Without pupil dilation · color fundus photograph · 848 x 848 pixels · 45° field of view · camera: NIDEK AFC-230 — 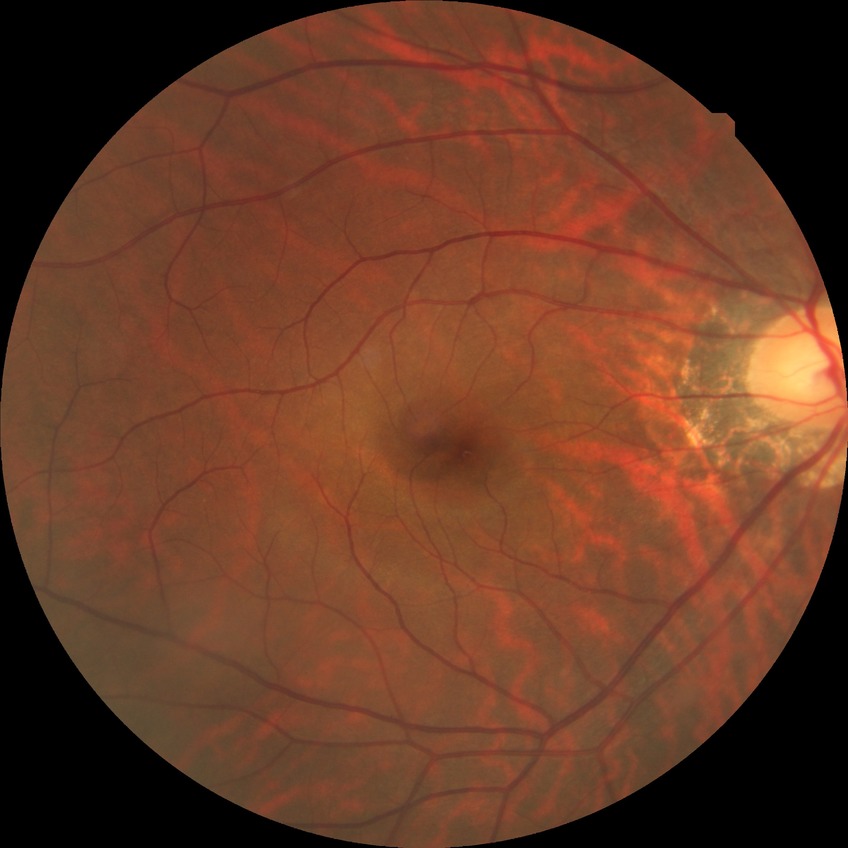
Diabetic retinopathy stage: no diabetic retinopathy.